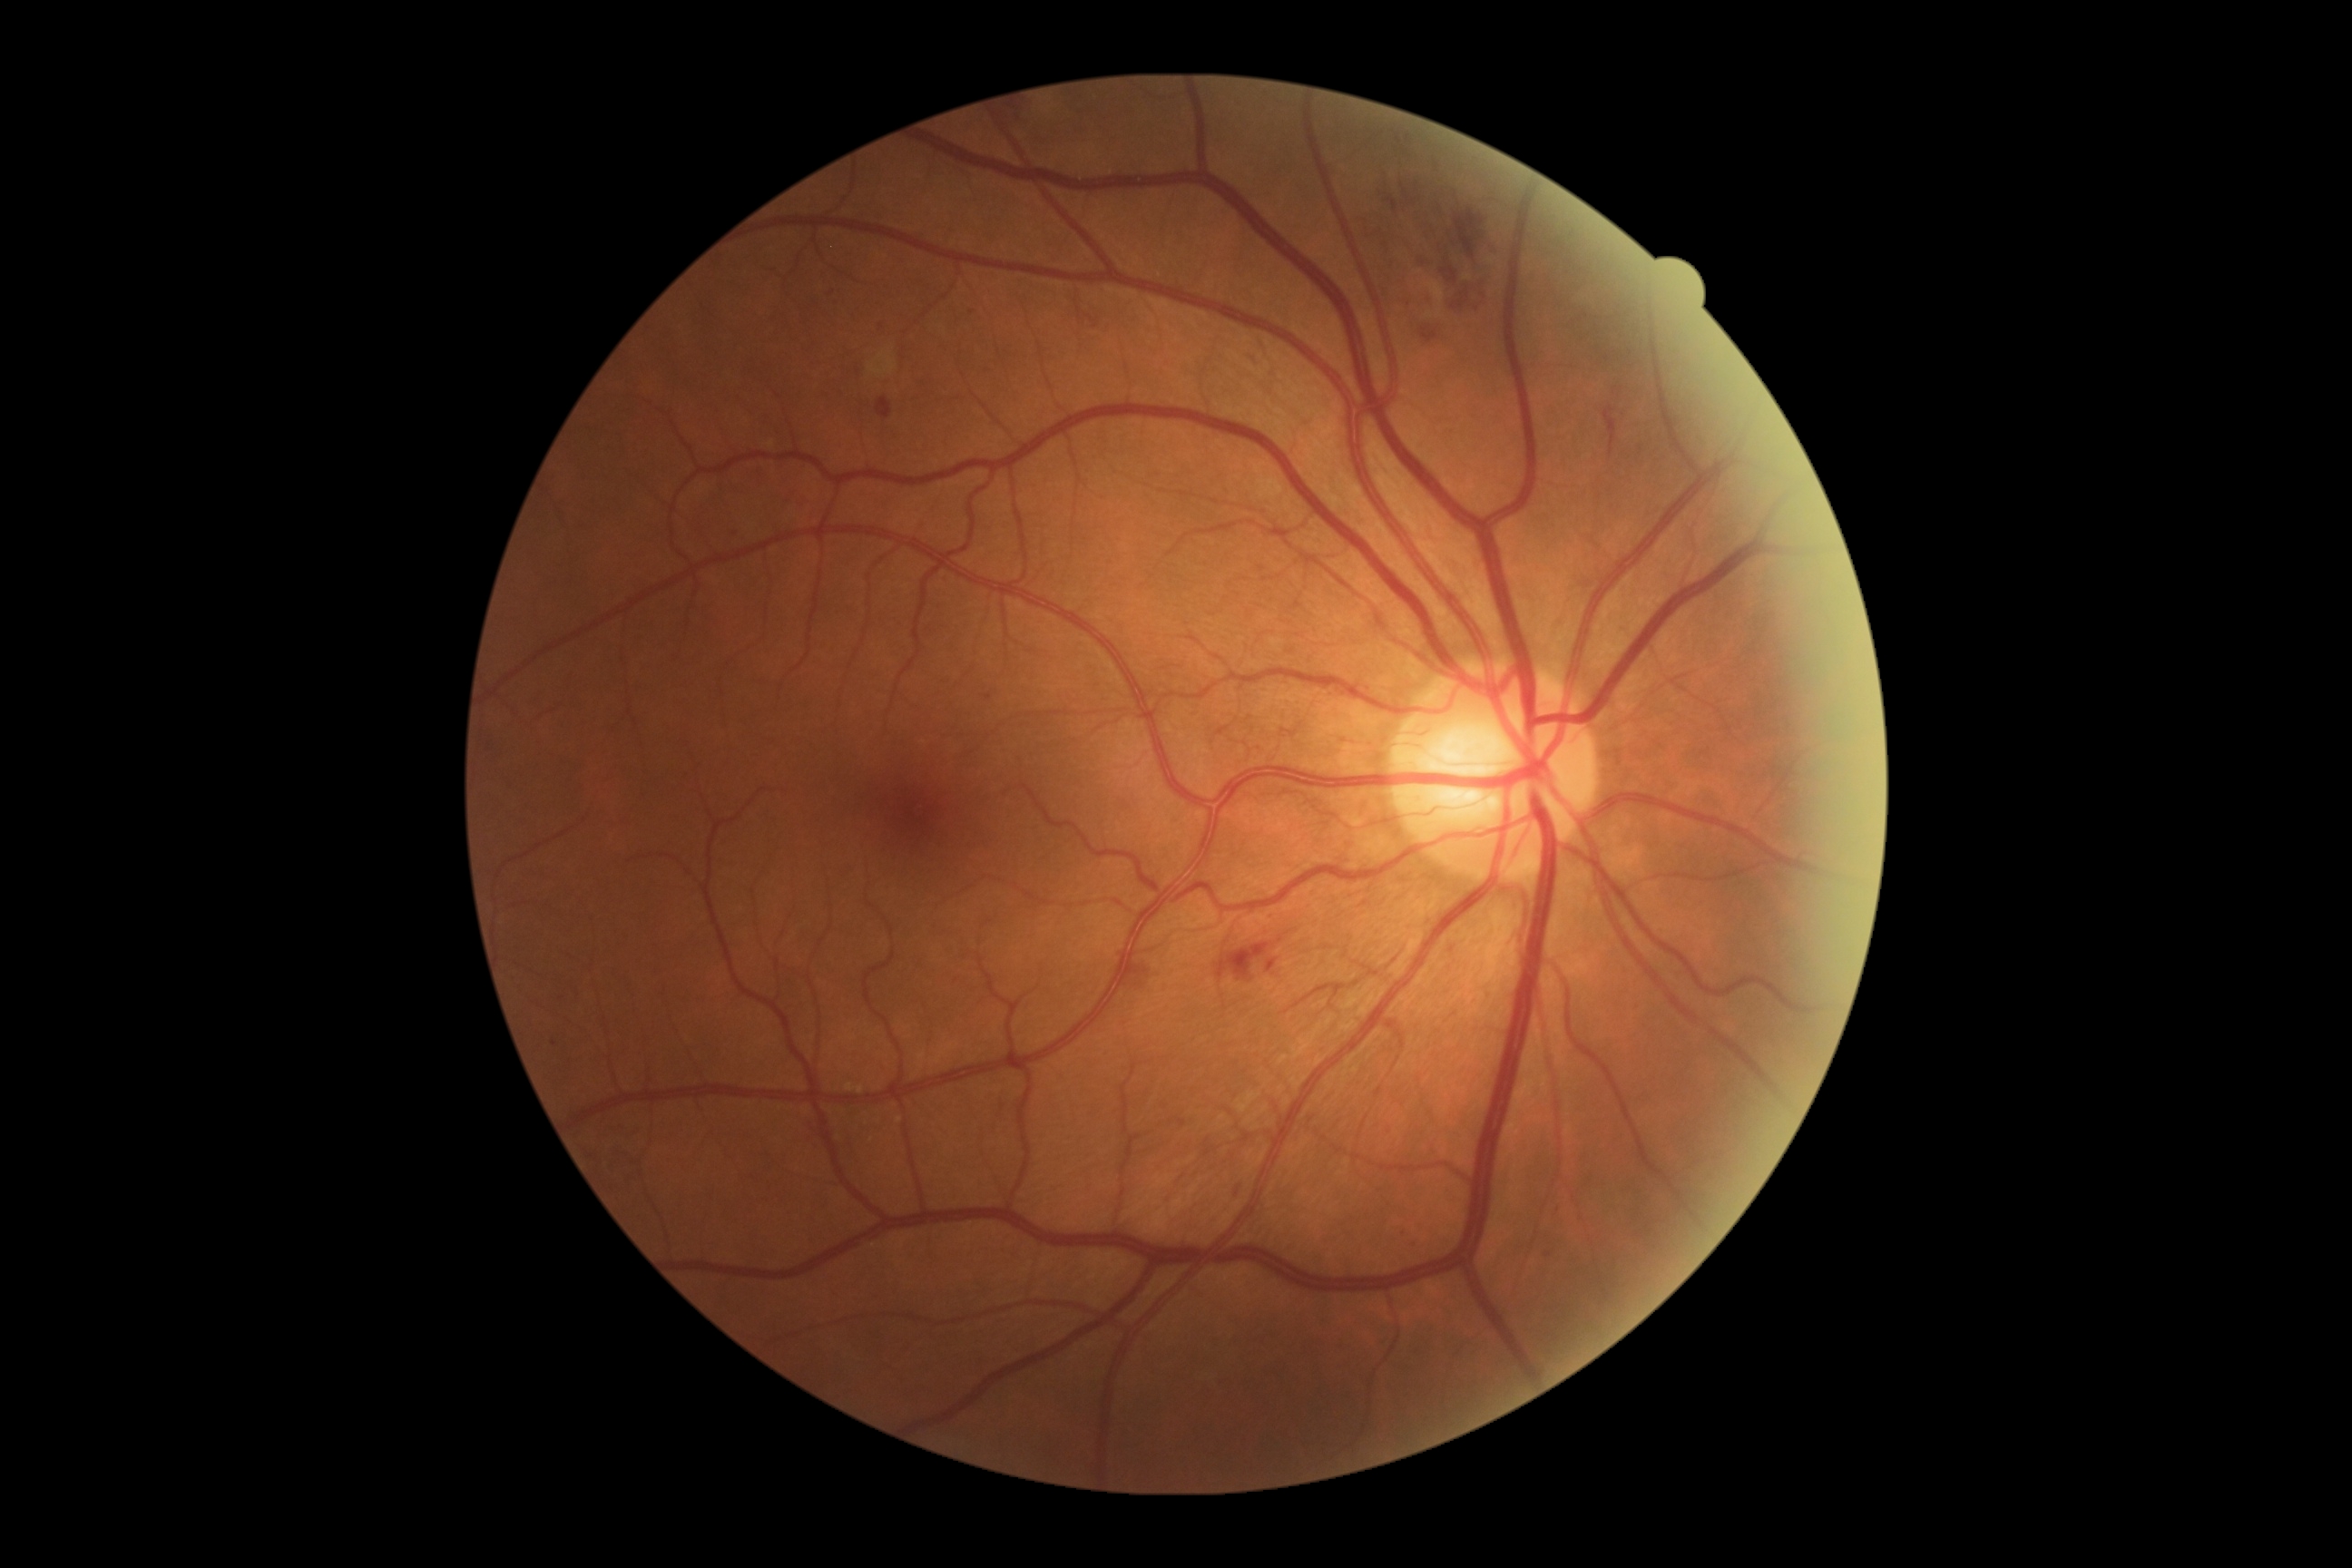 retinopathy grade = 2 — more than just microaneurysms but less than severe NPDR.